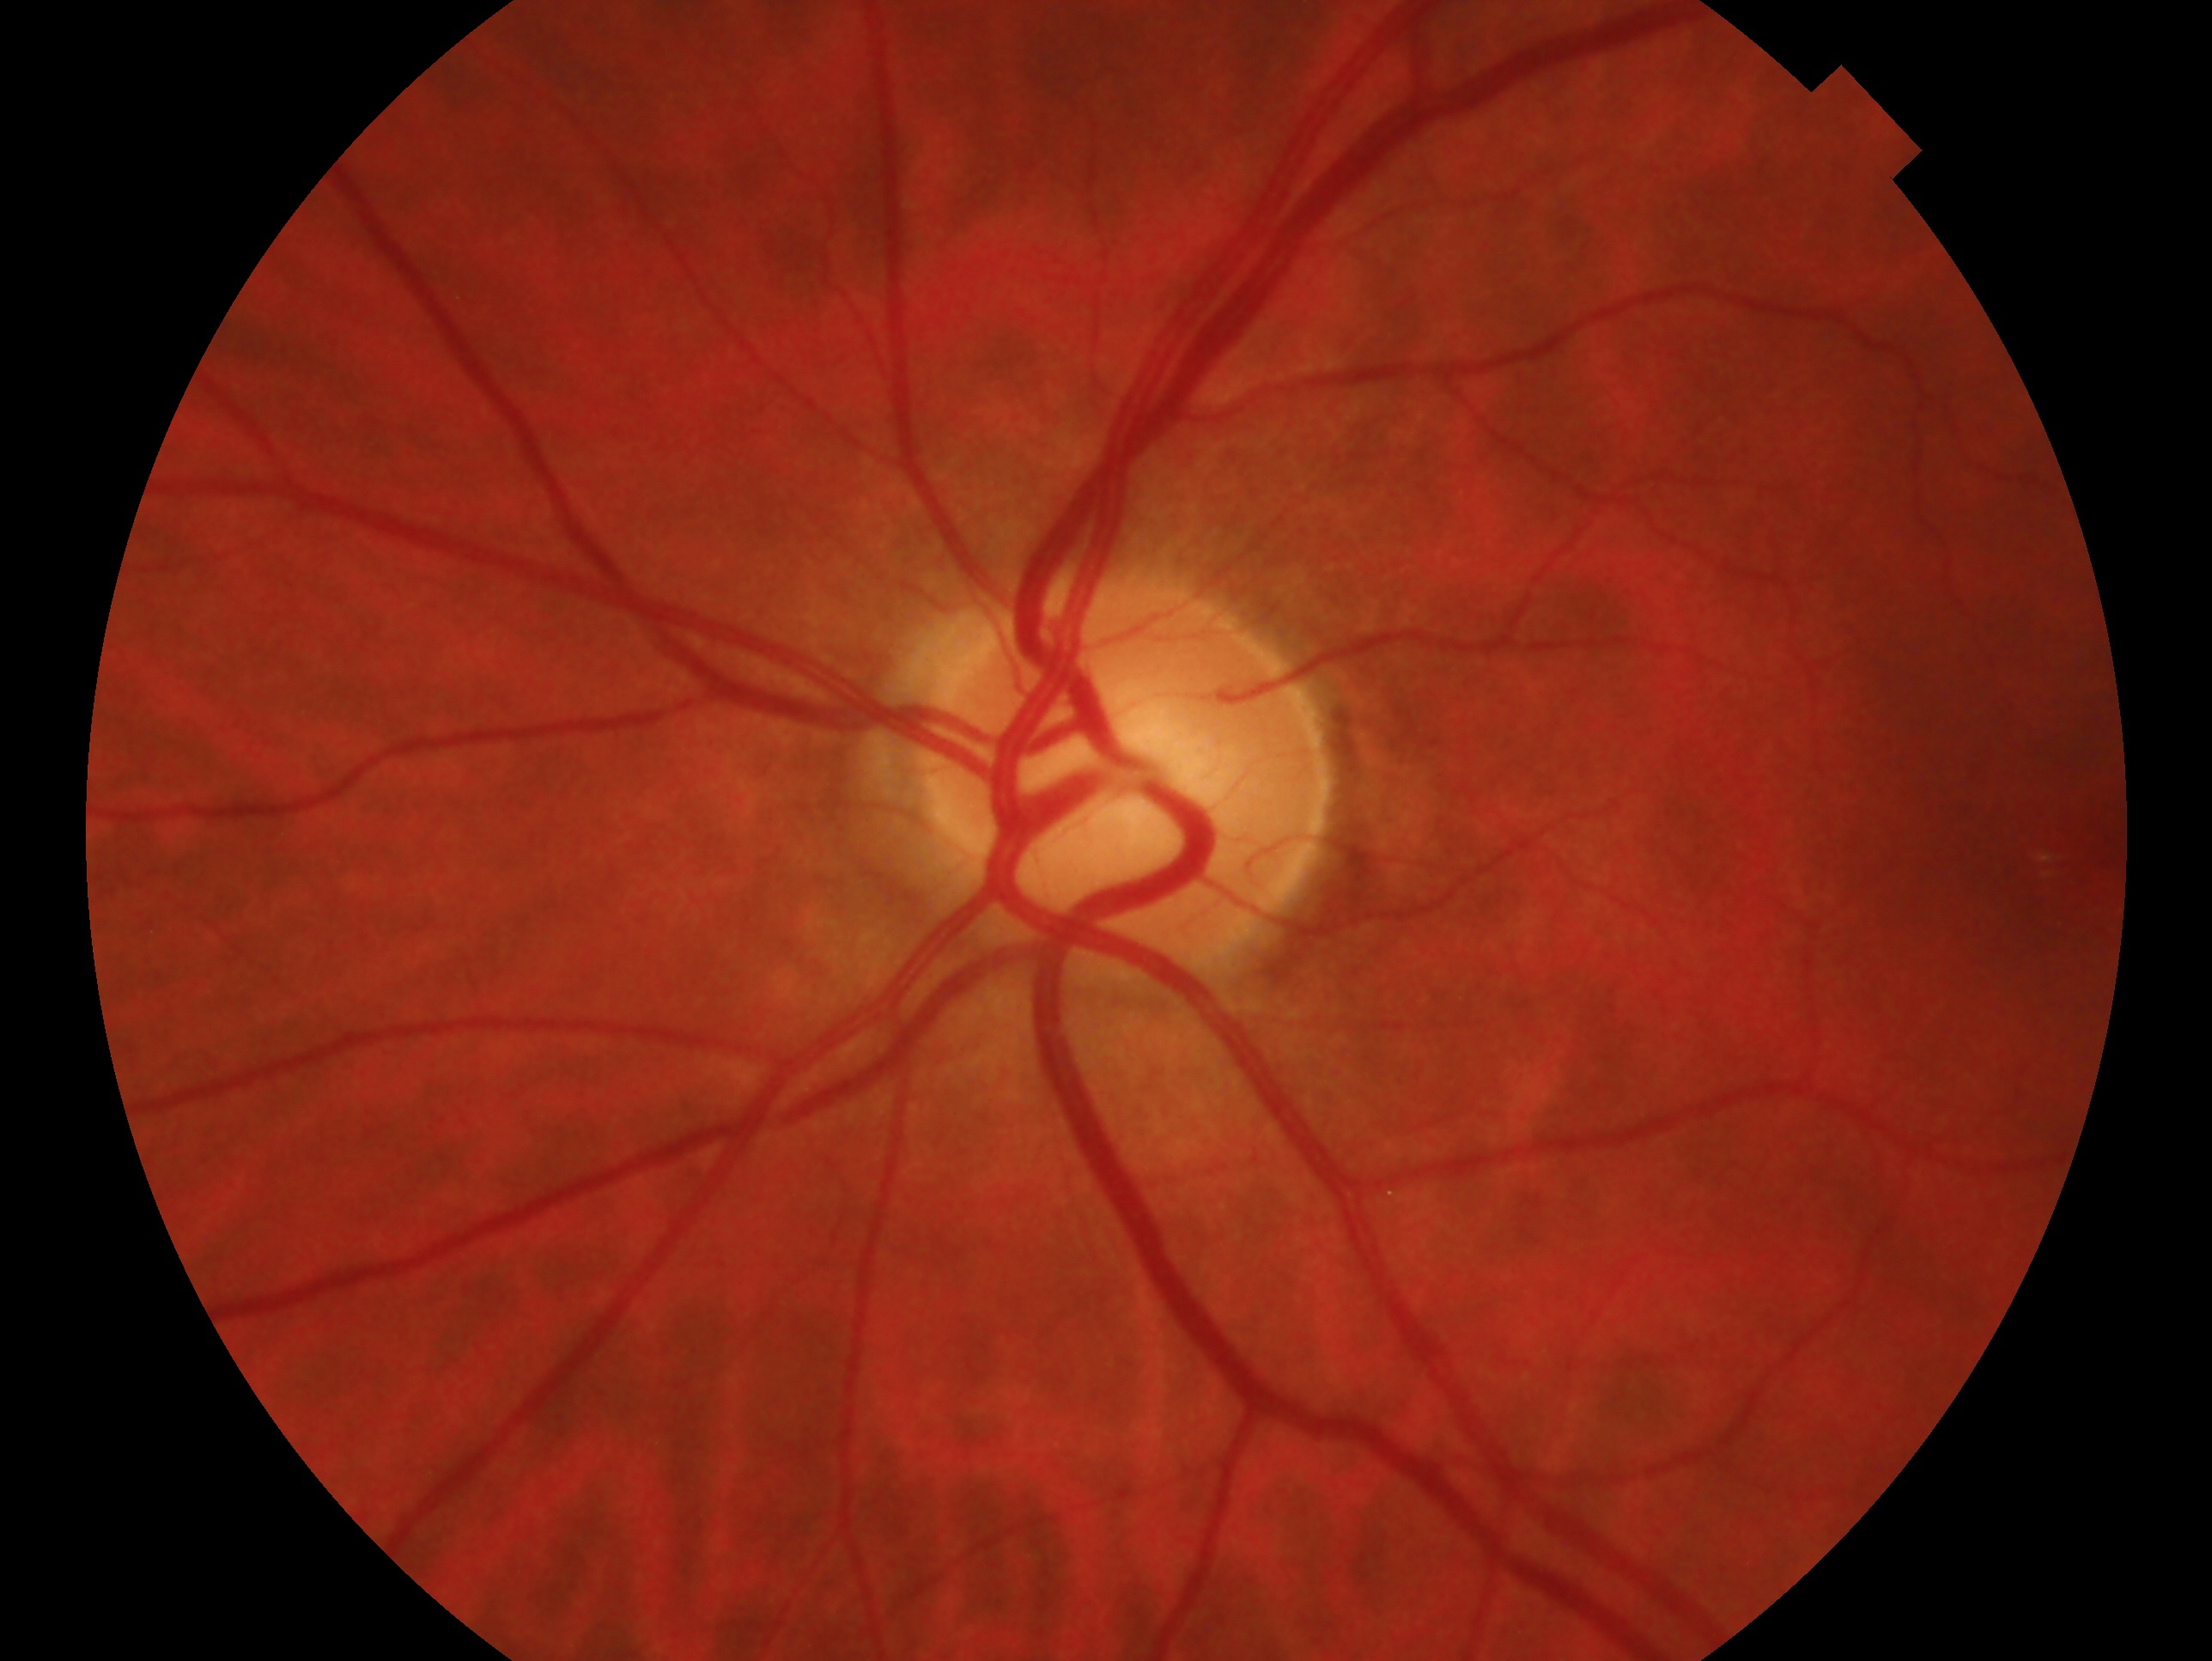

Q: What is the glaucoma diagnosis?
A: no glaucomatous findings
Q: Right or left eye?
A: left eye